RetCam wide-field infant fundus image: 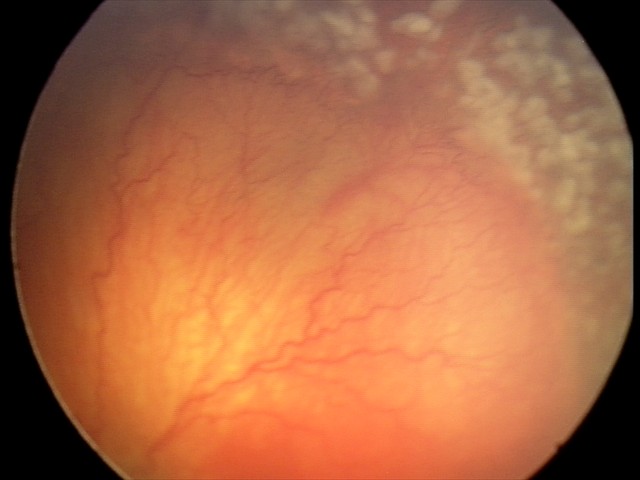 With plus disease. Diagnosis from this screening exam: aggressive retinopathy of prematurity (A-ROP).